Image size 1659x2212.
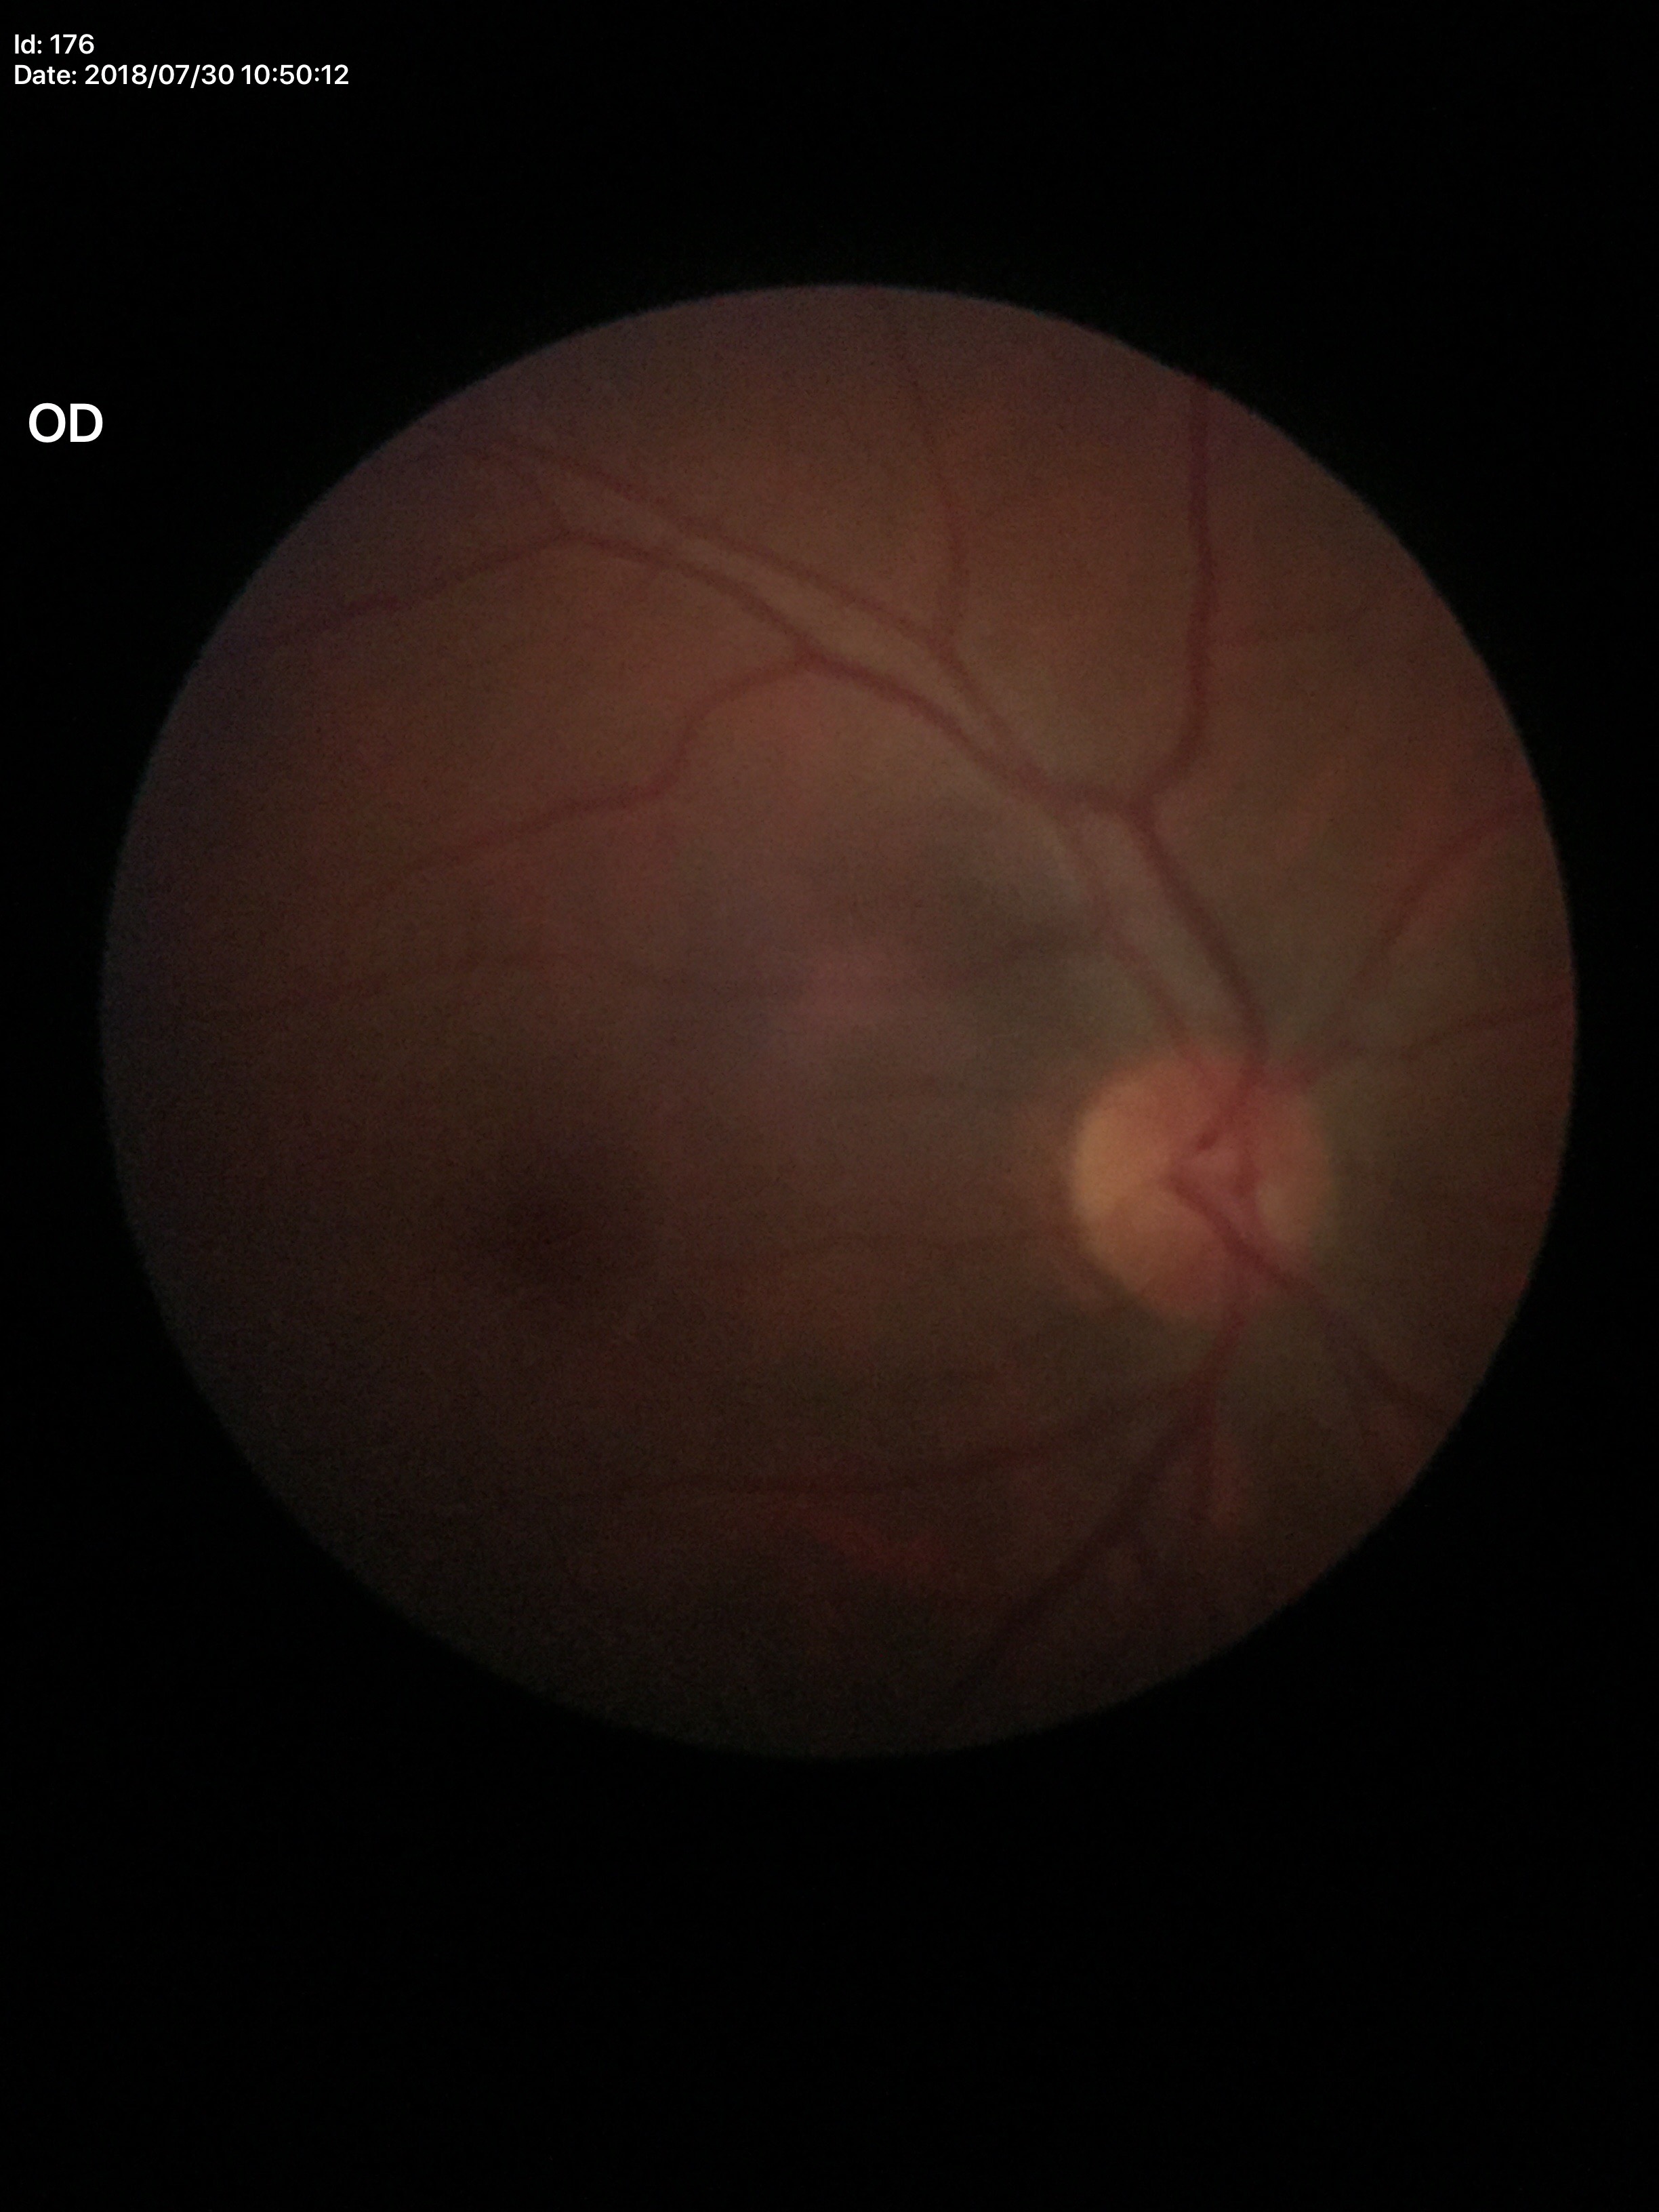
Glaucoma screening impression: negative.
VCDR of 0.46.
ACDR is 0.24.